Infant wide-field fundus photograph · image size 640x480 · Clarity RetCam 3, 130° FOV — 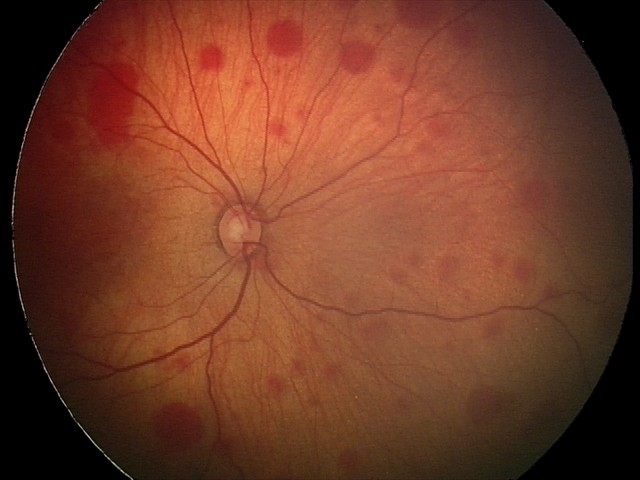
Screening diagnosis: retinal hemorrhages.